Infant wide-field retinal image — 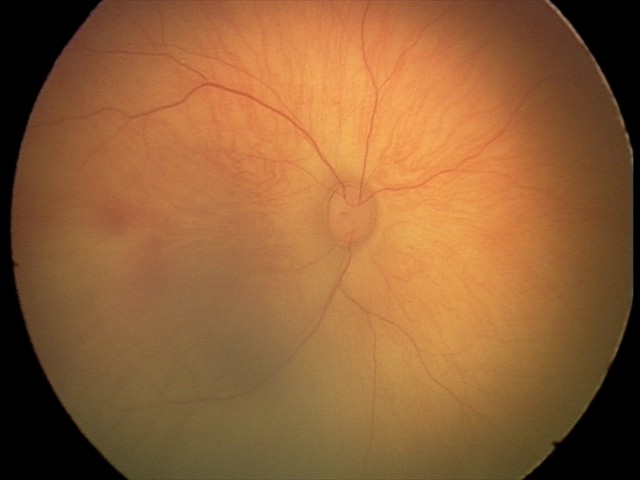 Screening series with retinal hemorrhages.